Color fundus image, 50° FOV:
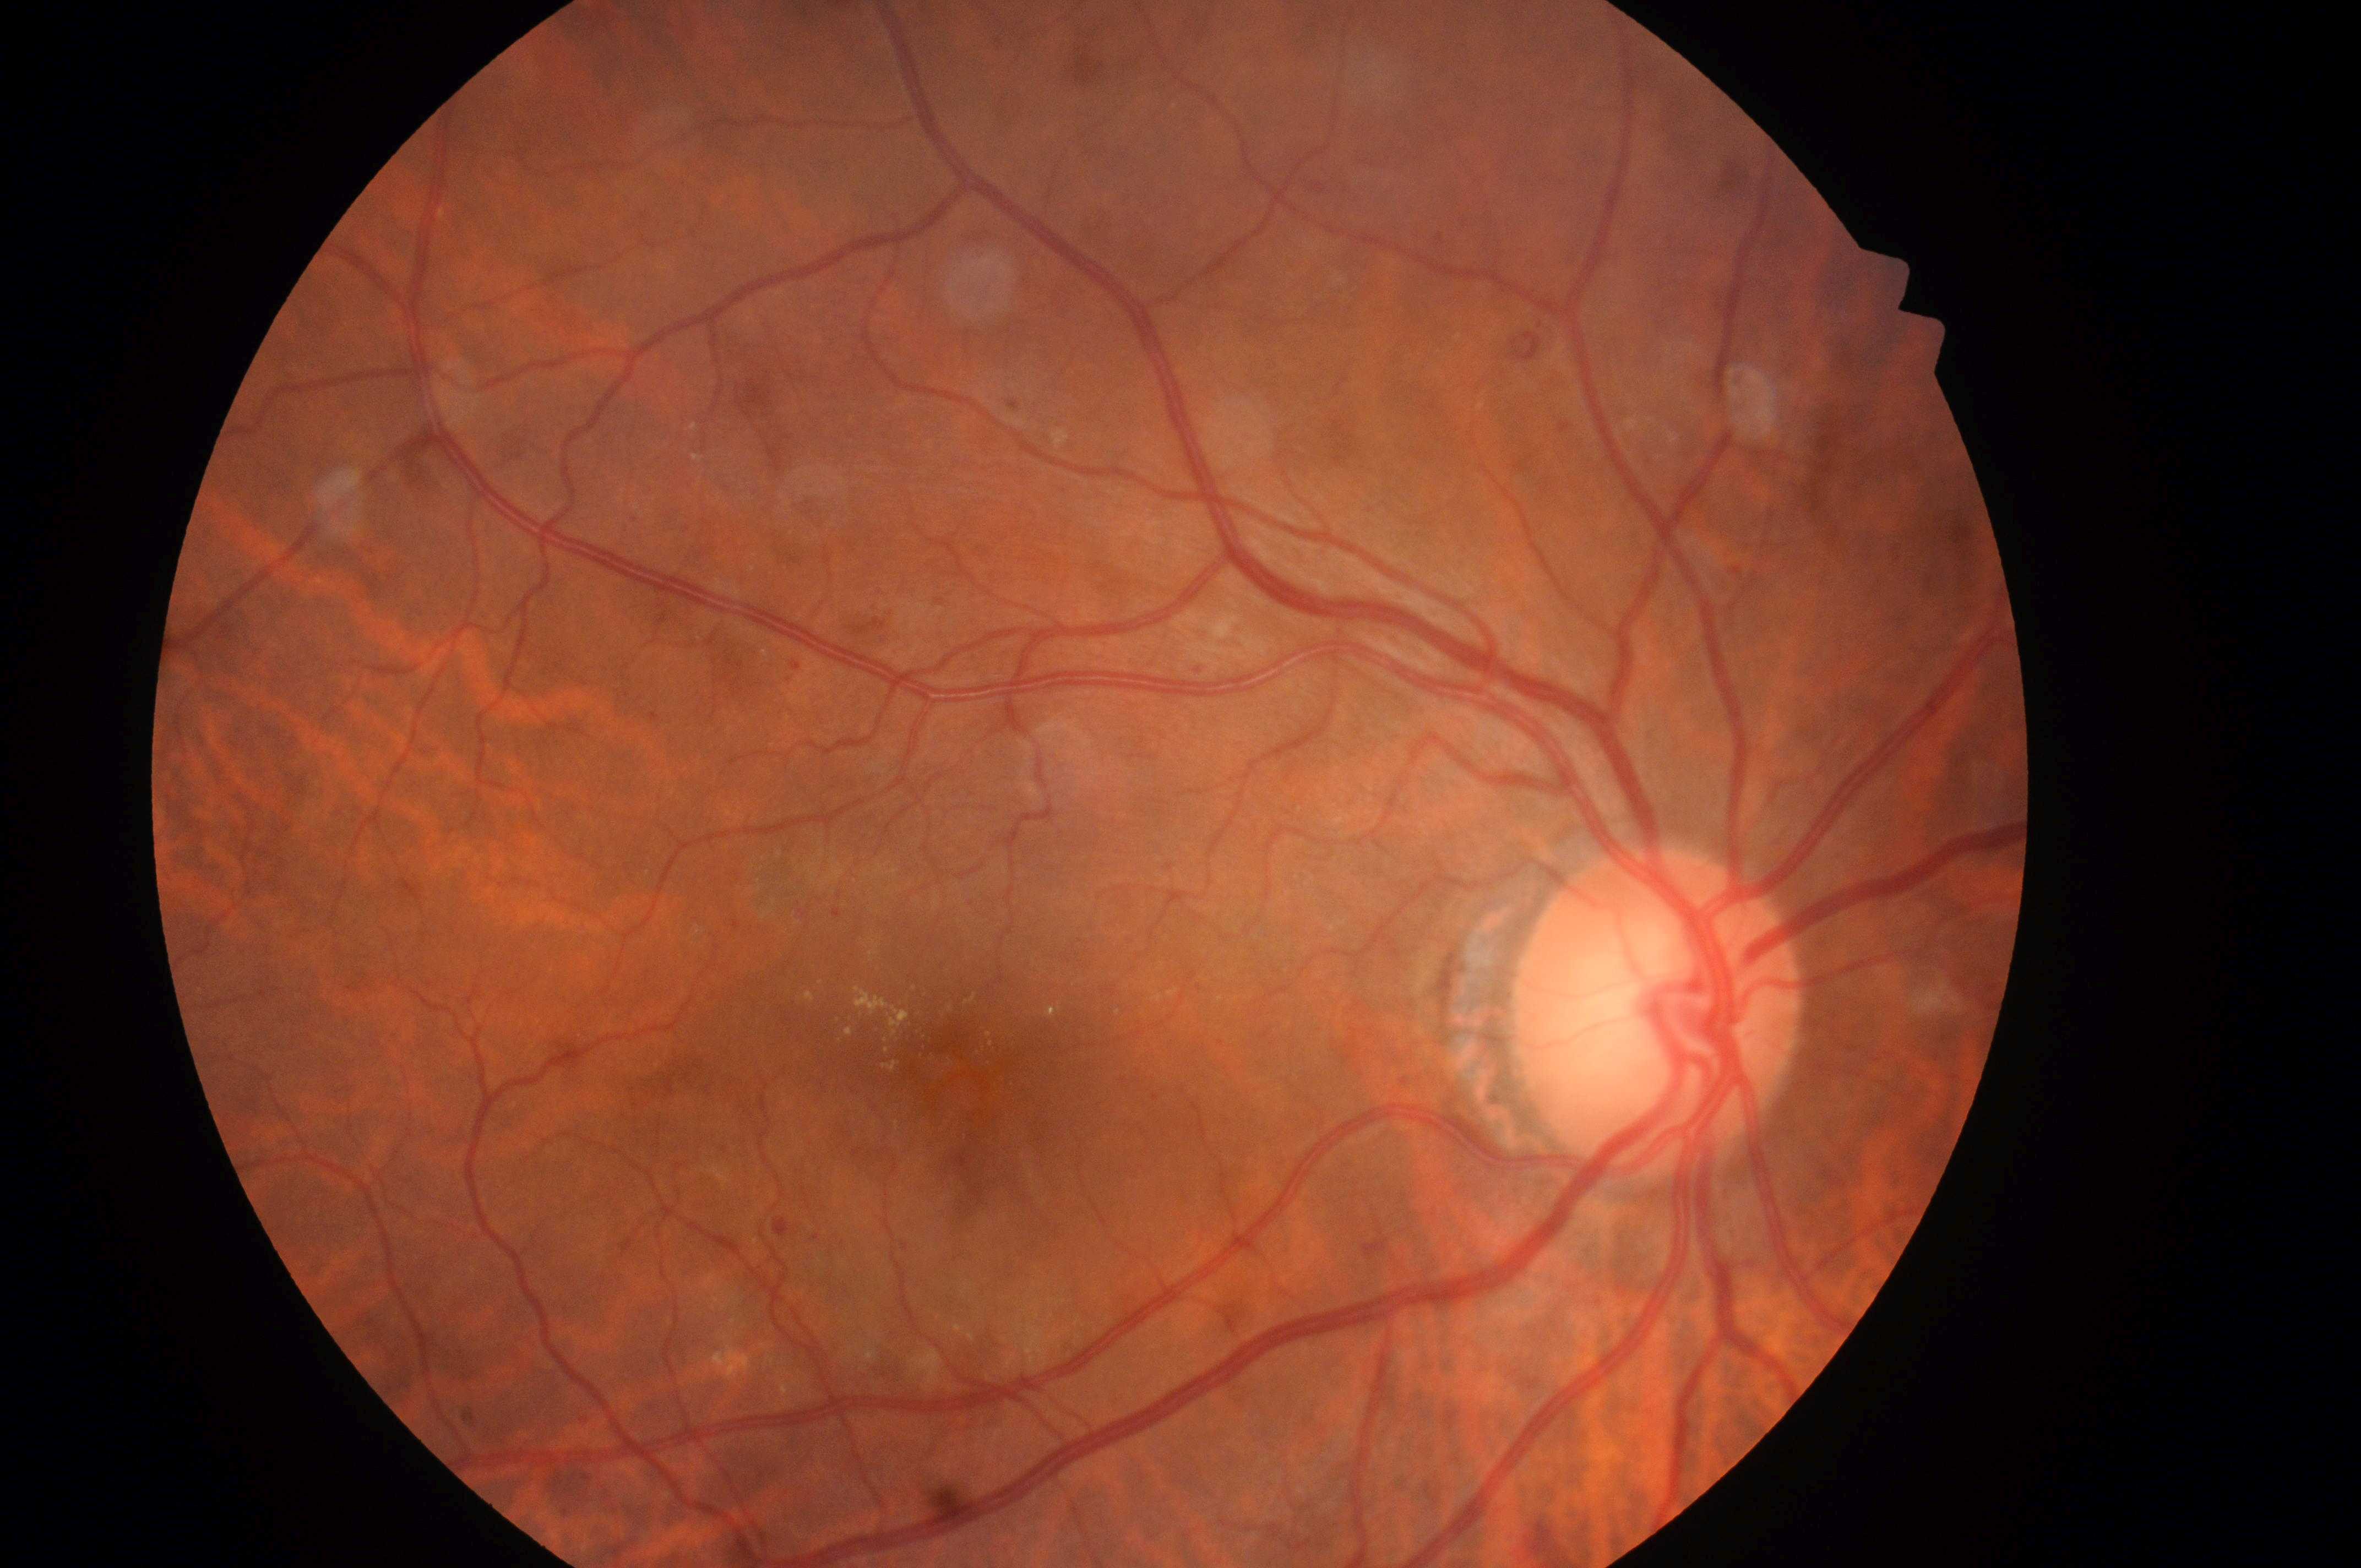
Q: What is the laterality?
A: OD
Q: What is the DME risk grade?
A: 2/2
Q: Locate the fovea.
A: (961, 1079)
Q: Locate the optic disc.
A: (1650, 1027)
Q: What is the DR grade?
A: 2/4